DR severity per modified Davis staging, FOV: 45 degrees:
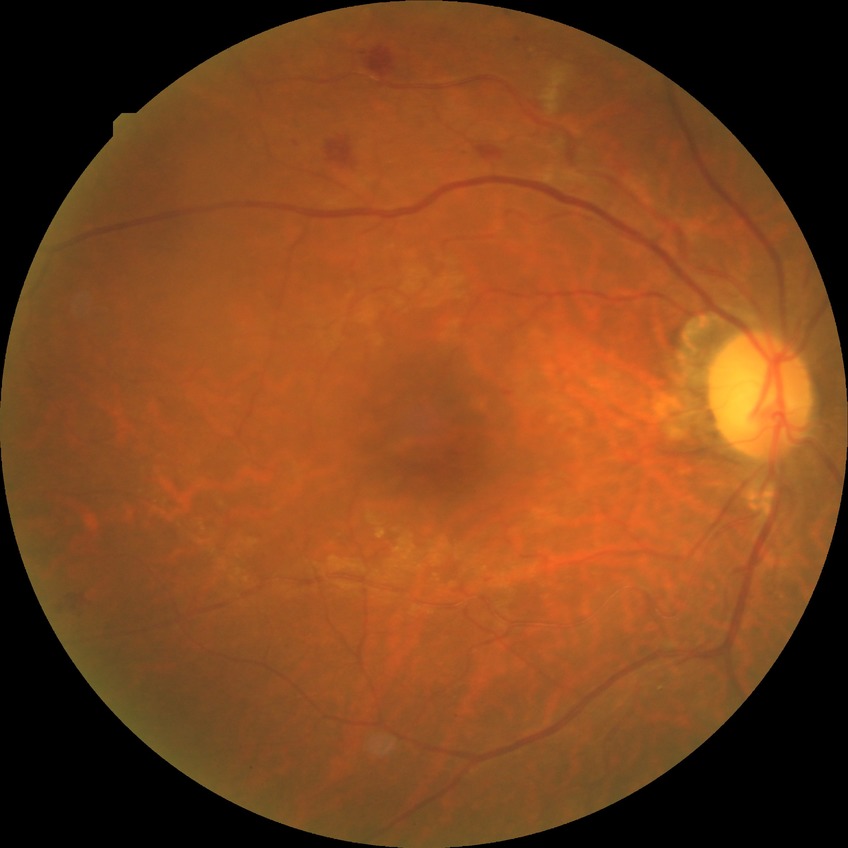

diabetic retinopathy (DR): simple diabetic retinopathy (SDR).